Color fundus image:
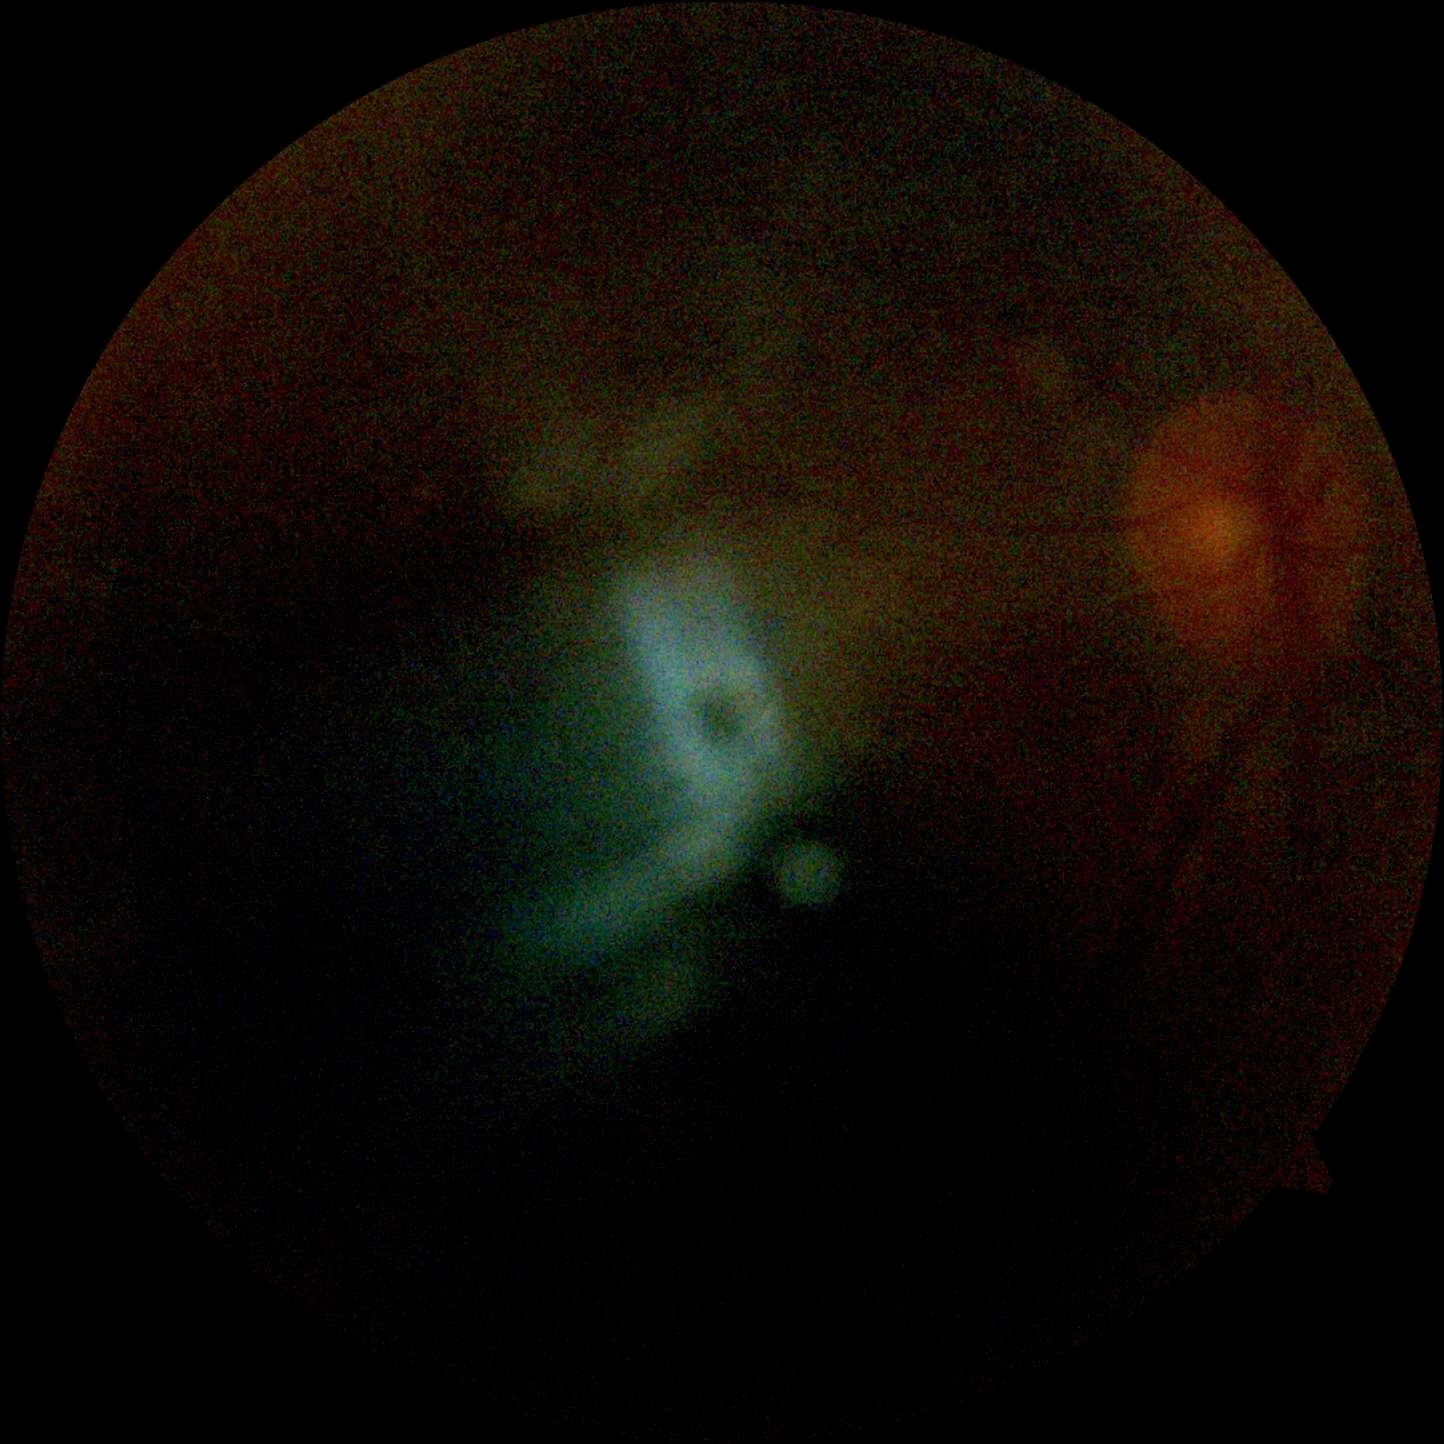

Annotations:
• retinopathy grade — ungradable
• image quality — insufficient for DR assessment